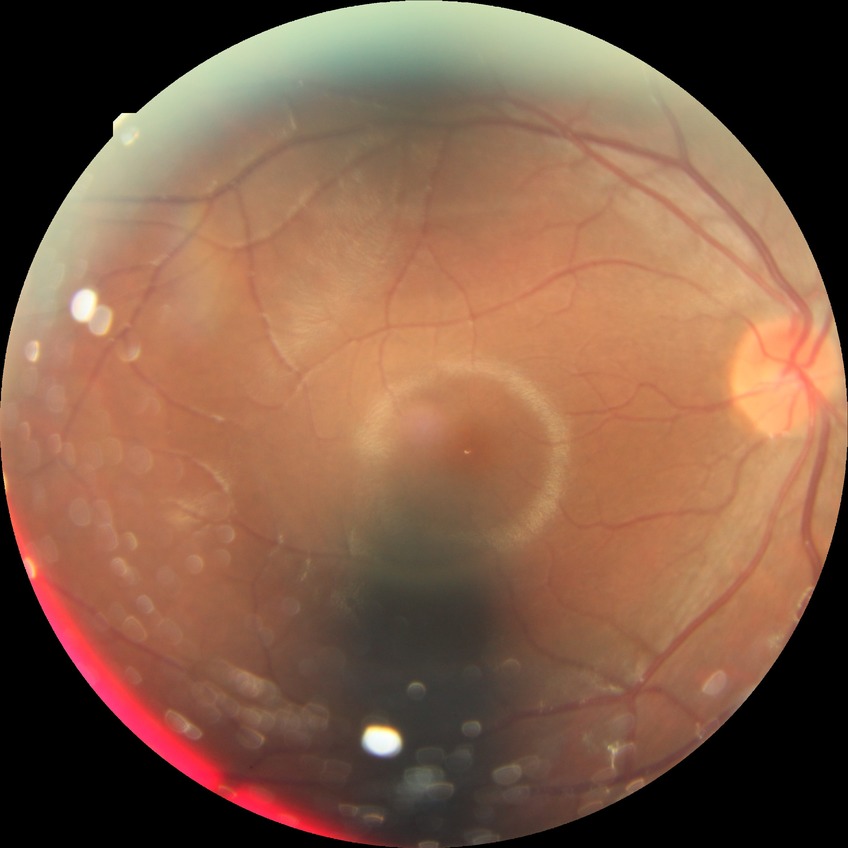

diabetic retinopathy (DR)@no diabetic retinopathy (NDR).